Retinal fundus photograph · 2352 x 1568 pixels: 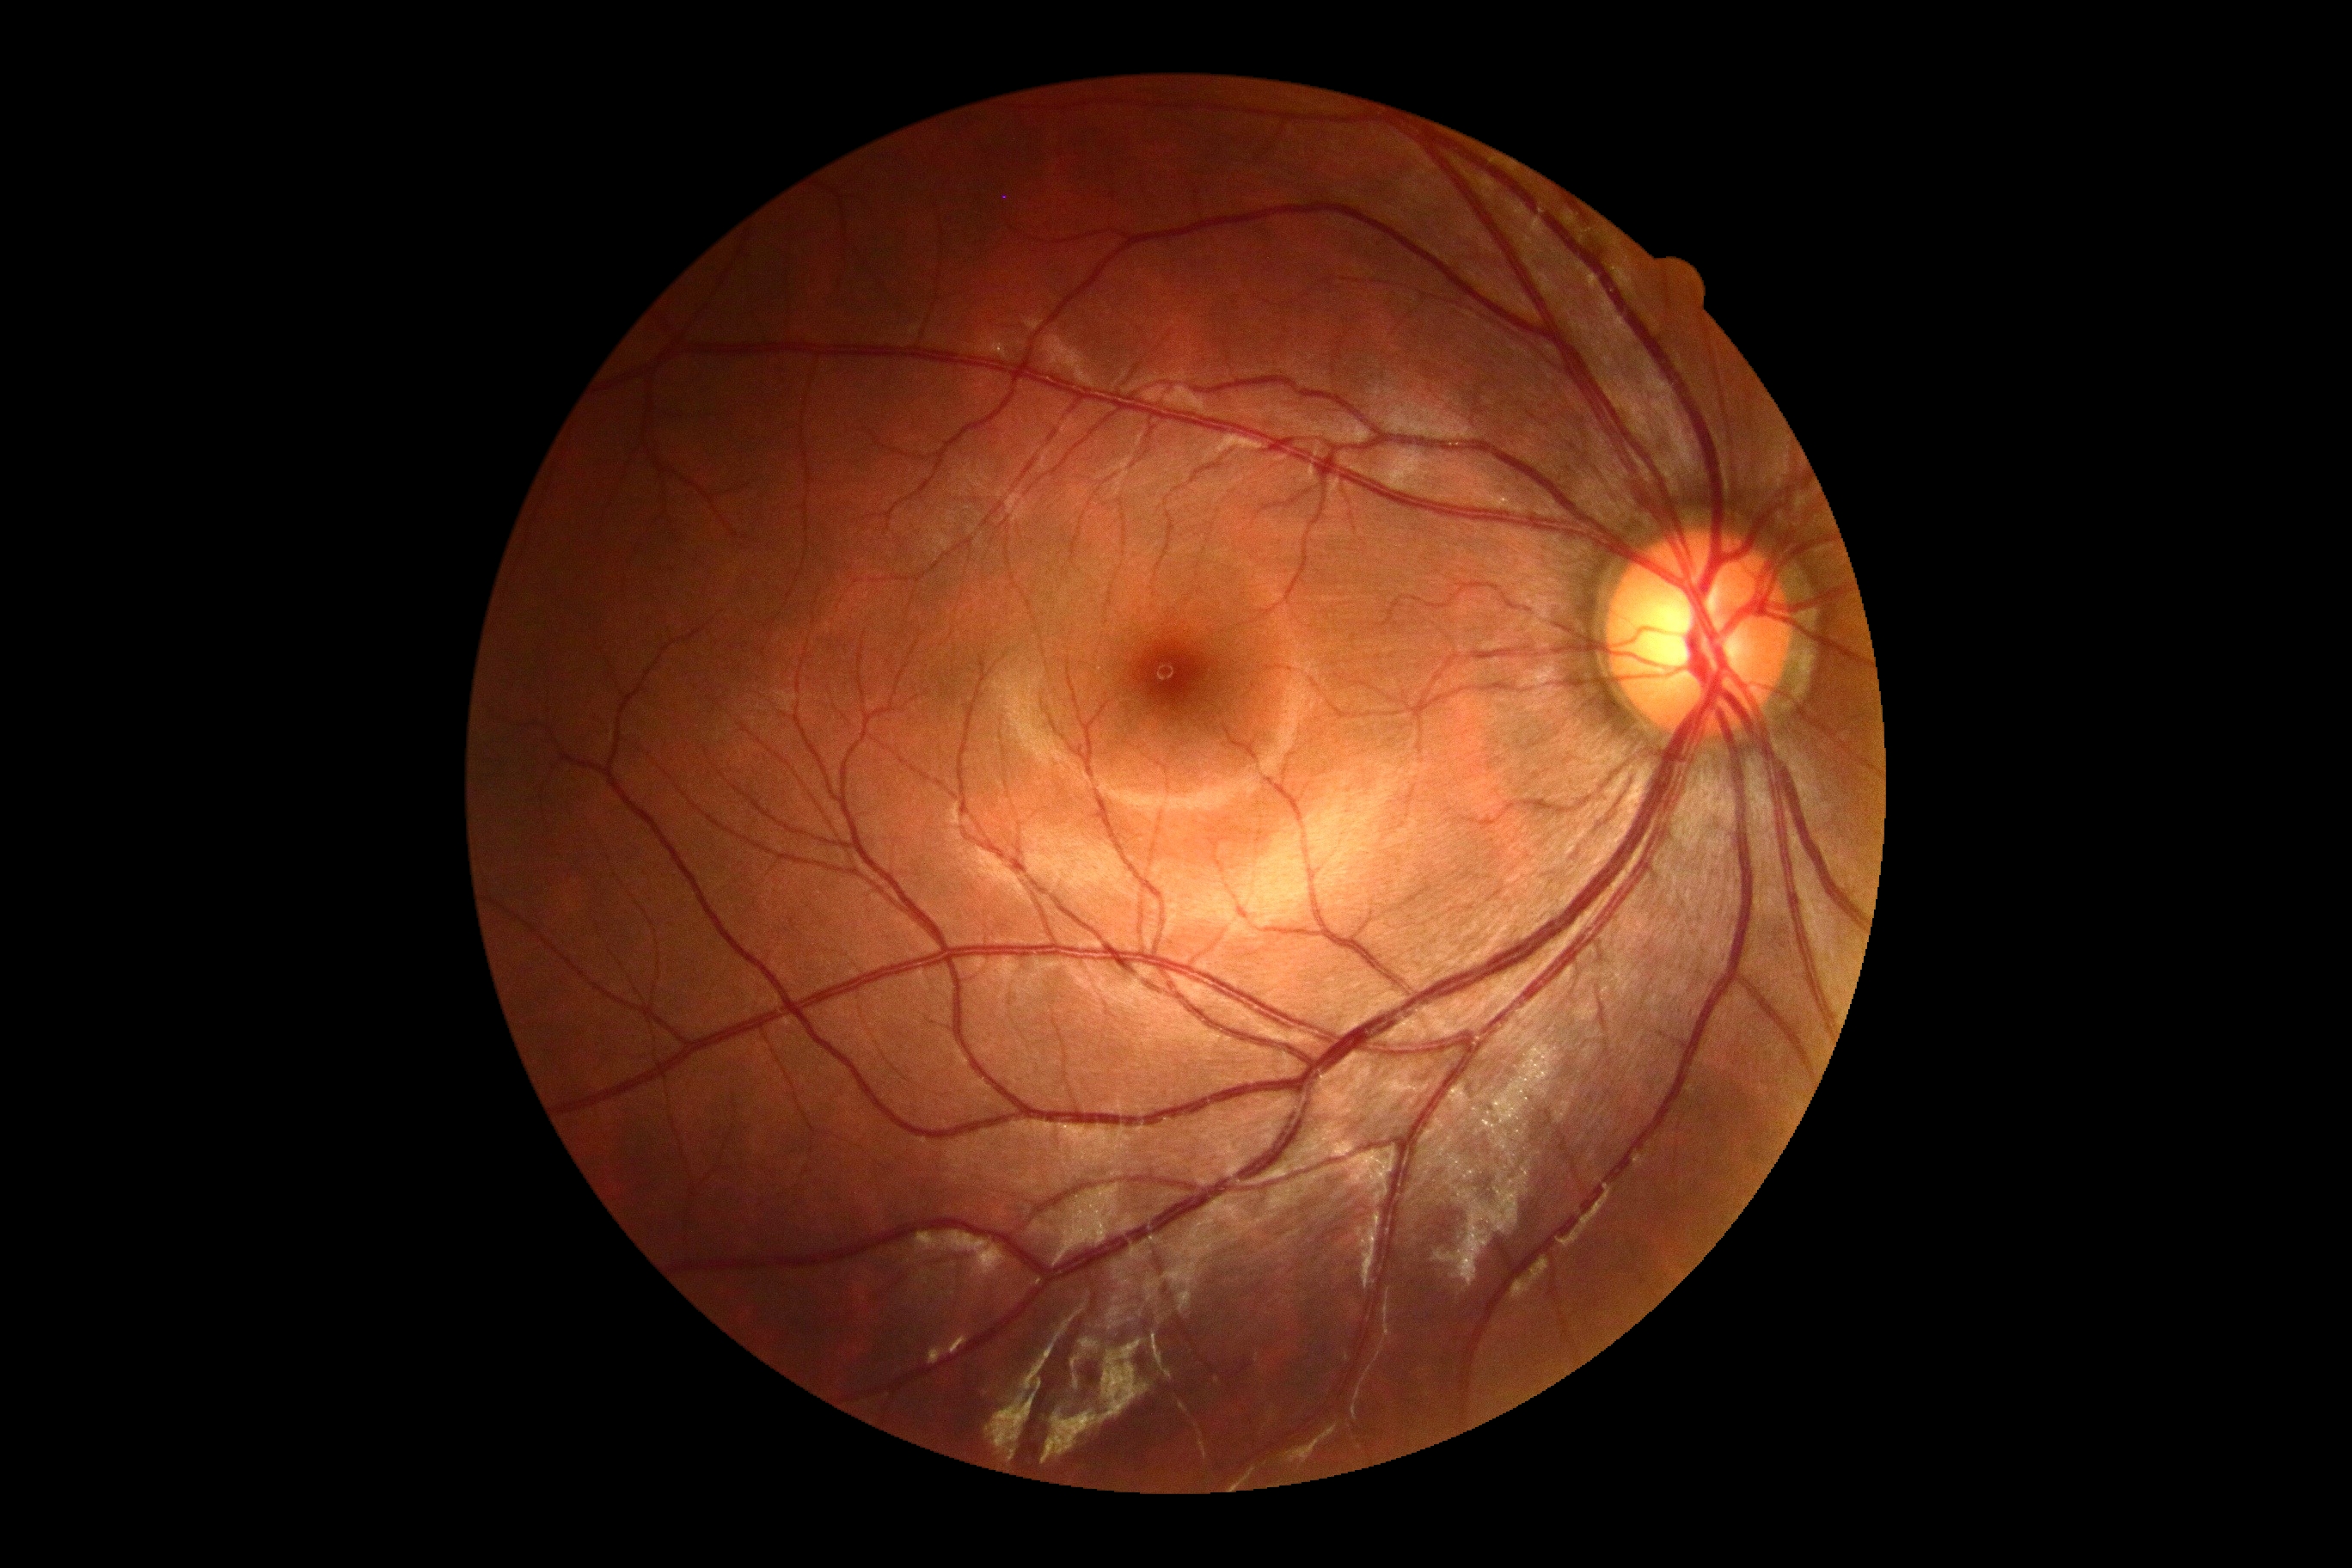 No diabetic retinal disease findings.
DR grade: 0.